Color fundus photograph.
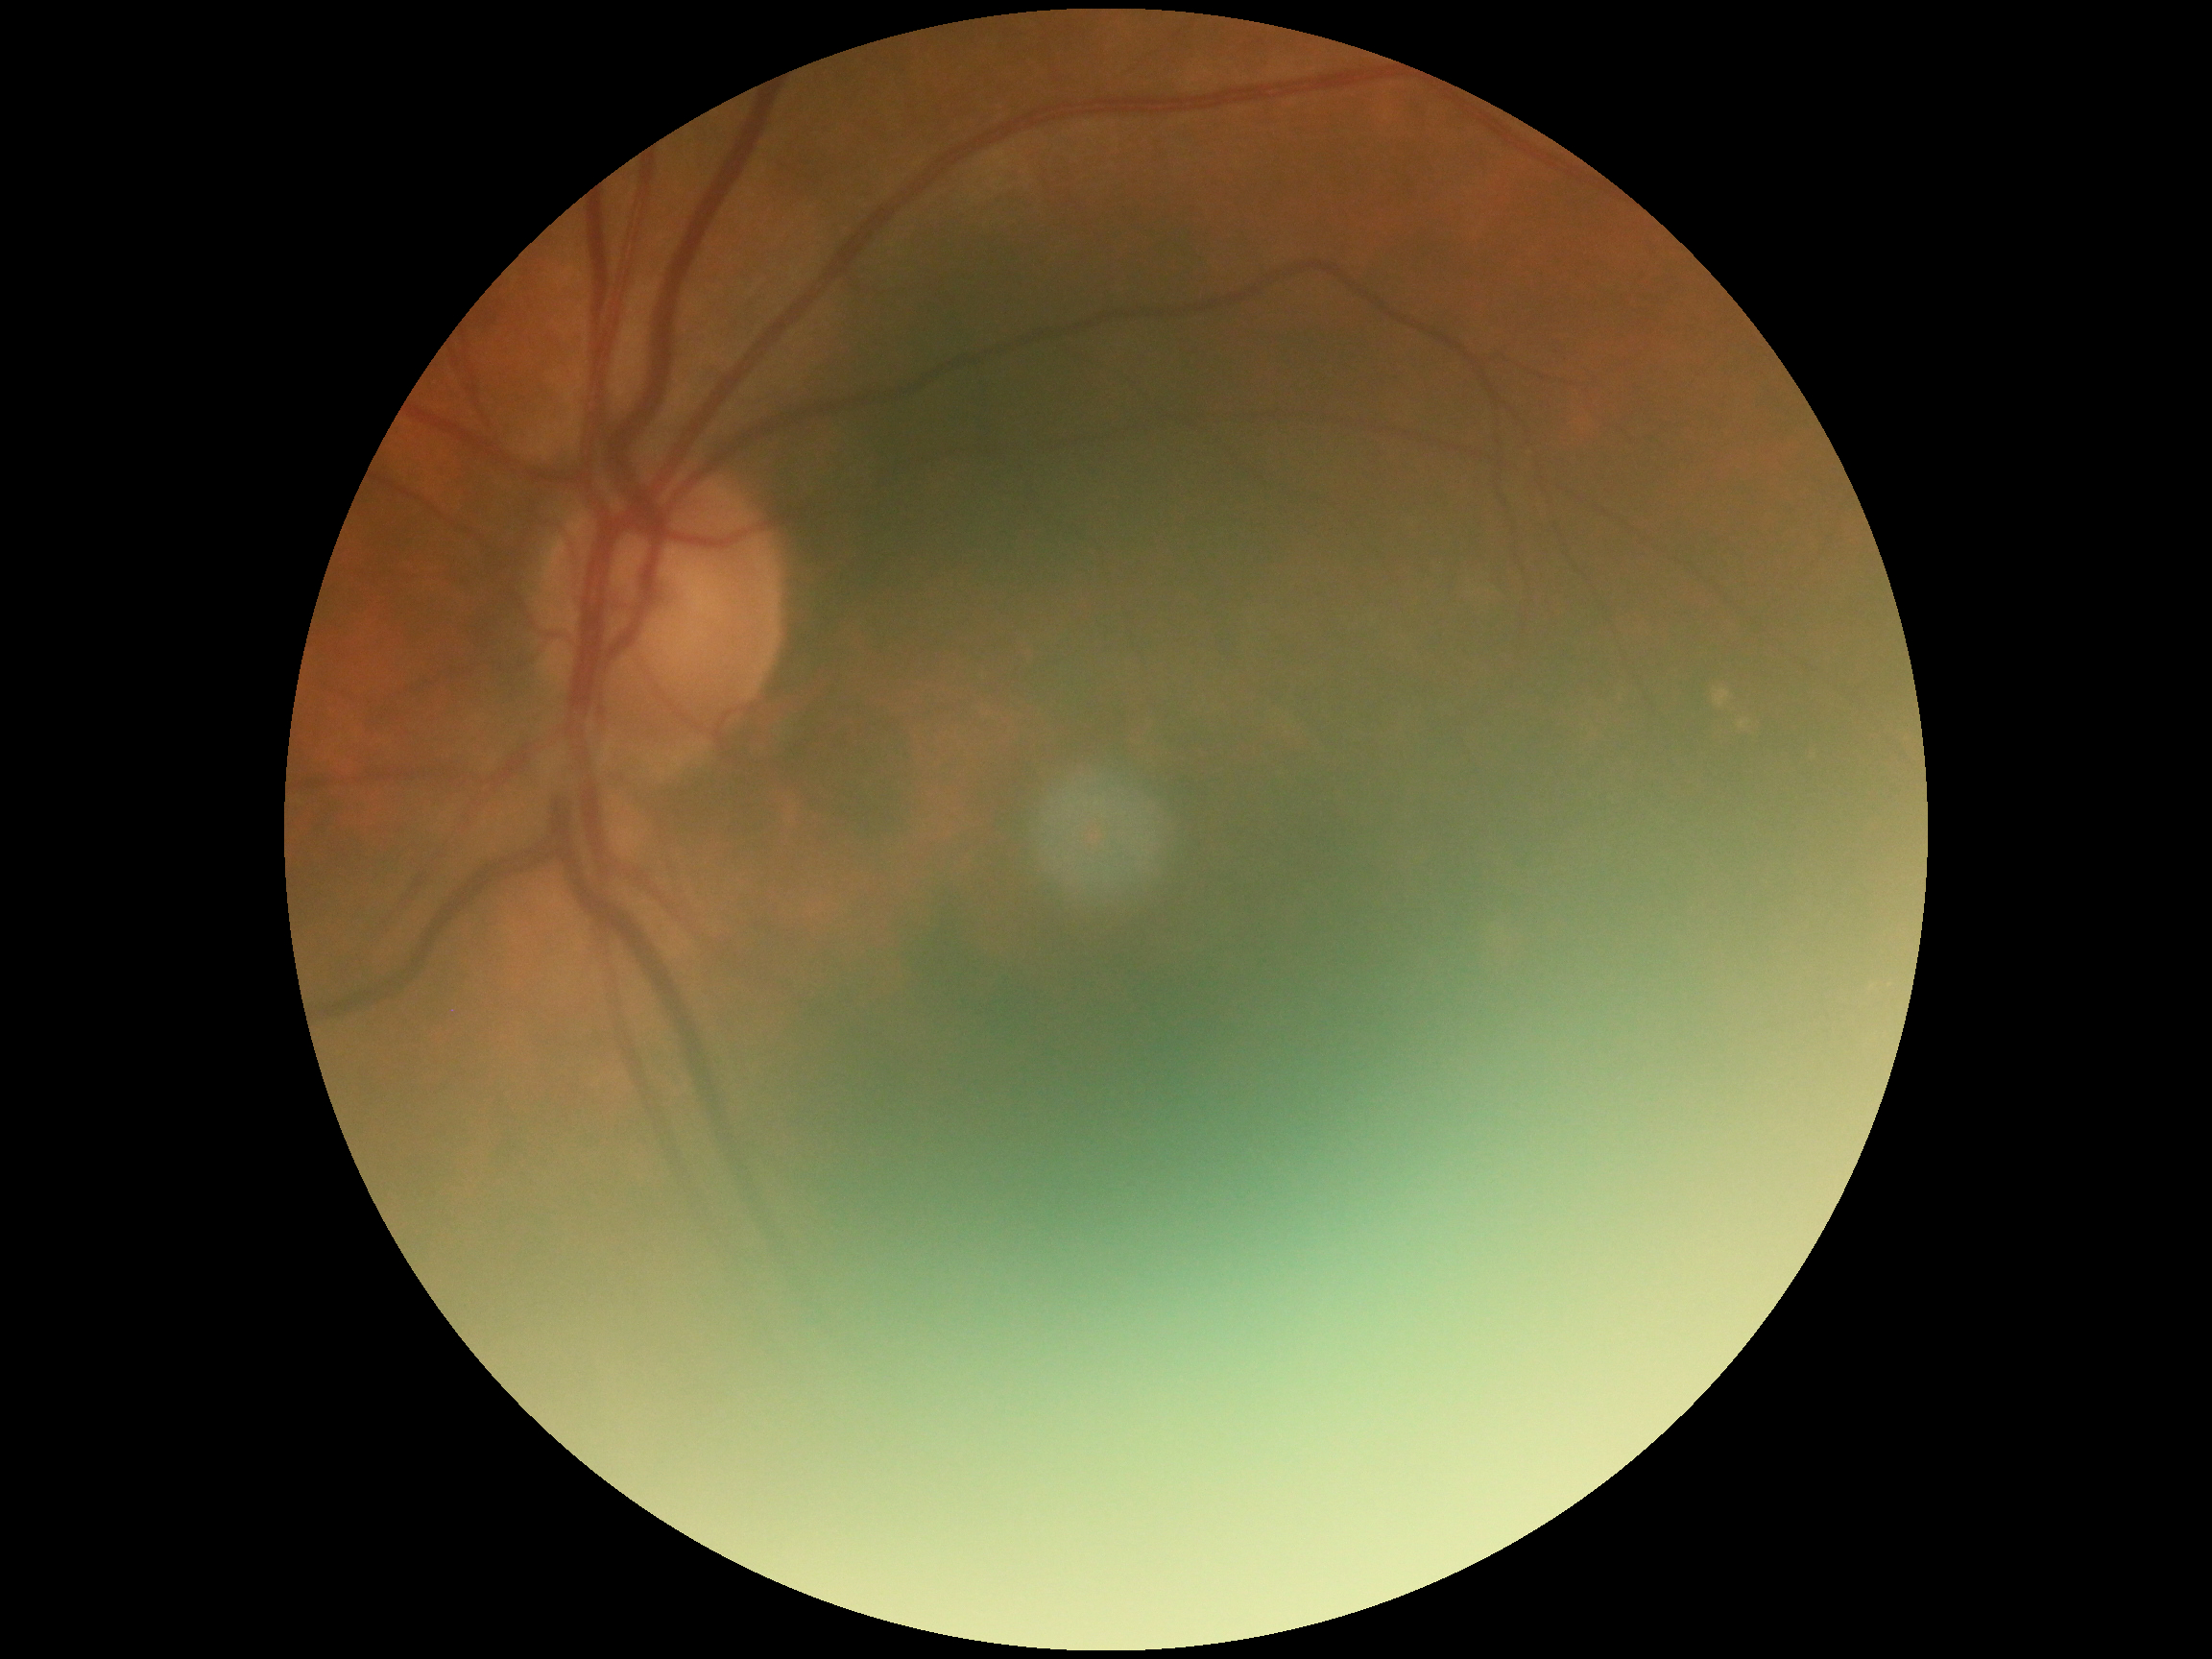

retinopathy: grade 0 (no apparent retinopathy)